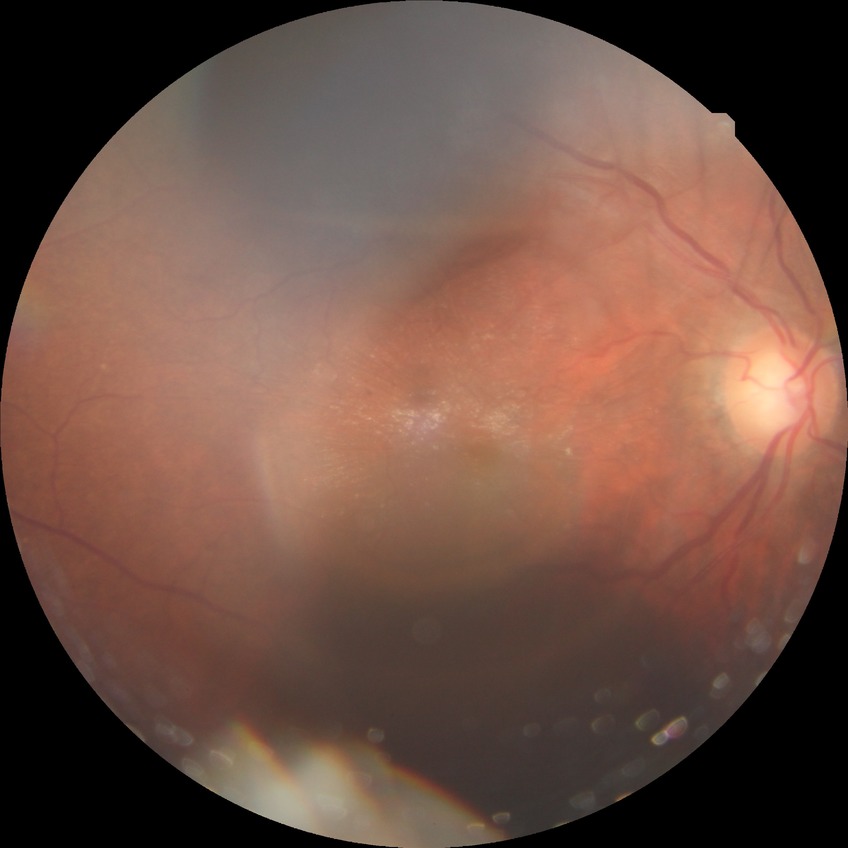

DR is SDR. Disease class: non-proliferative diabetic retinopathy.